FOV: 45 degrees; CFP: 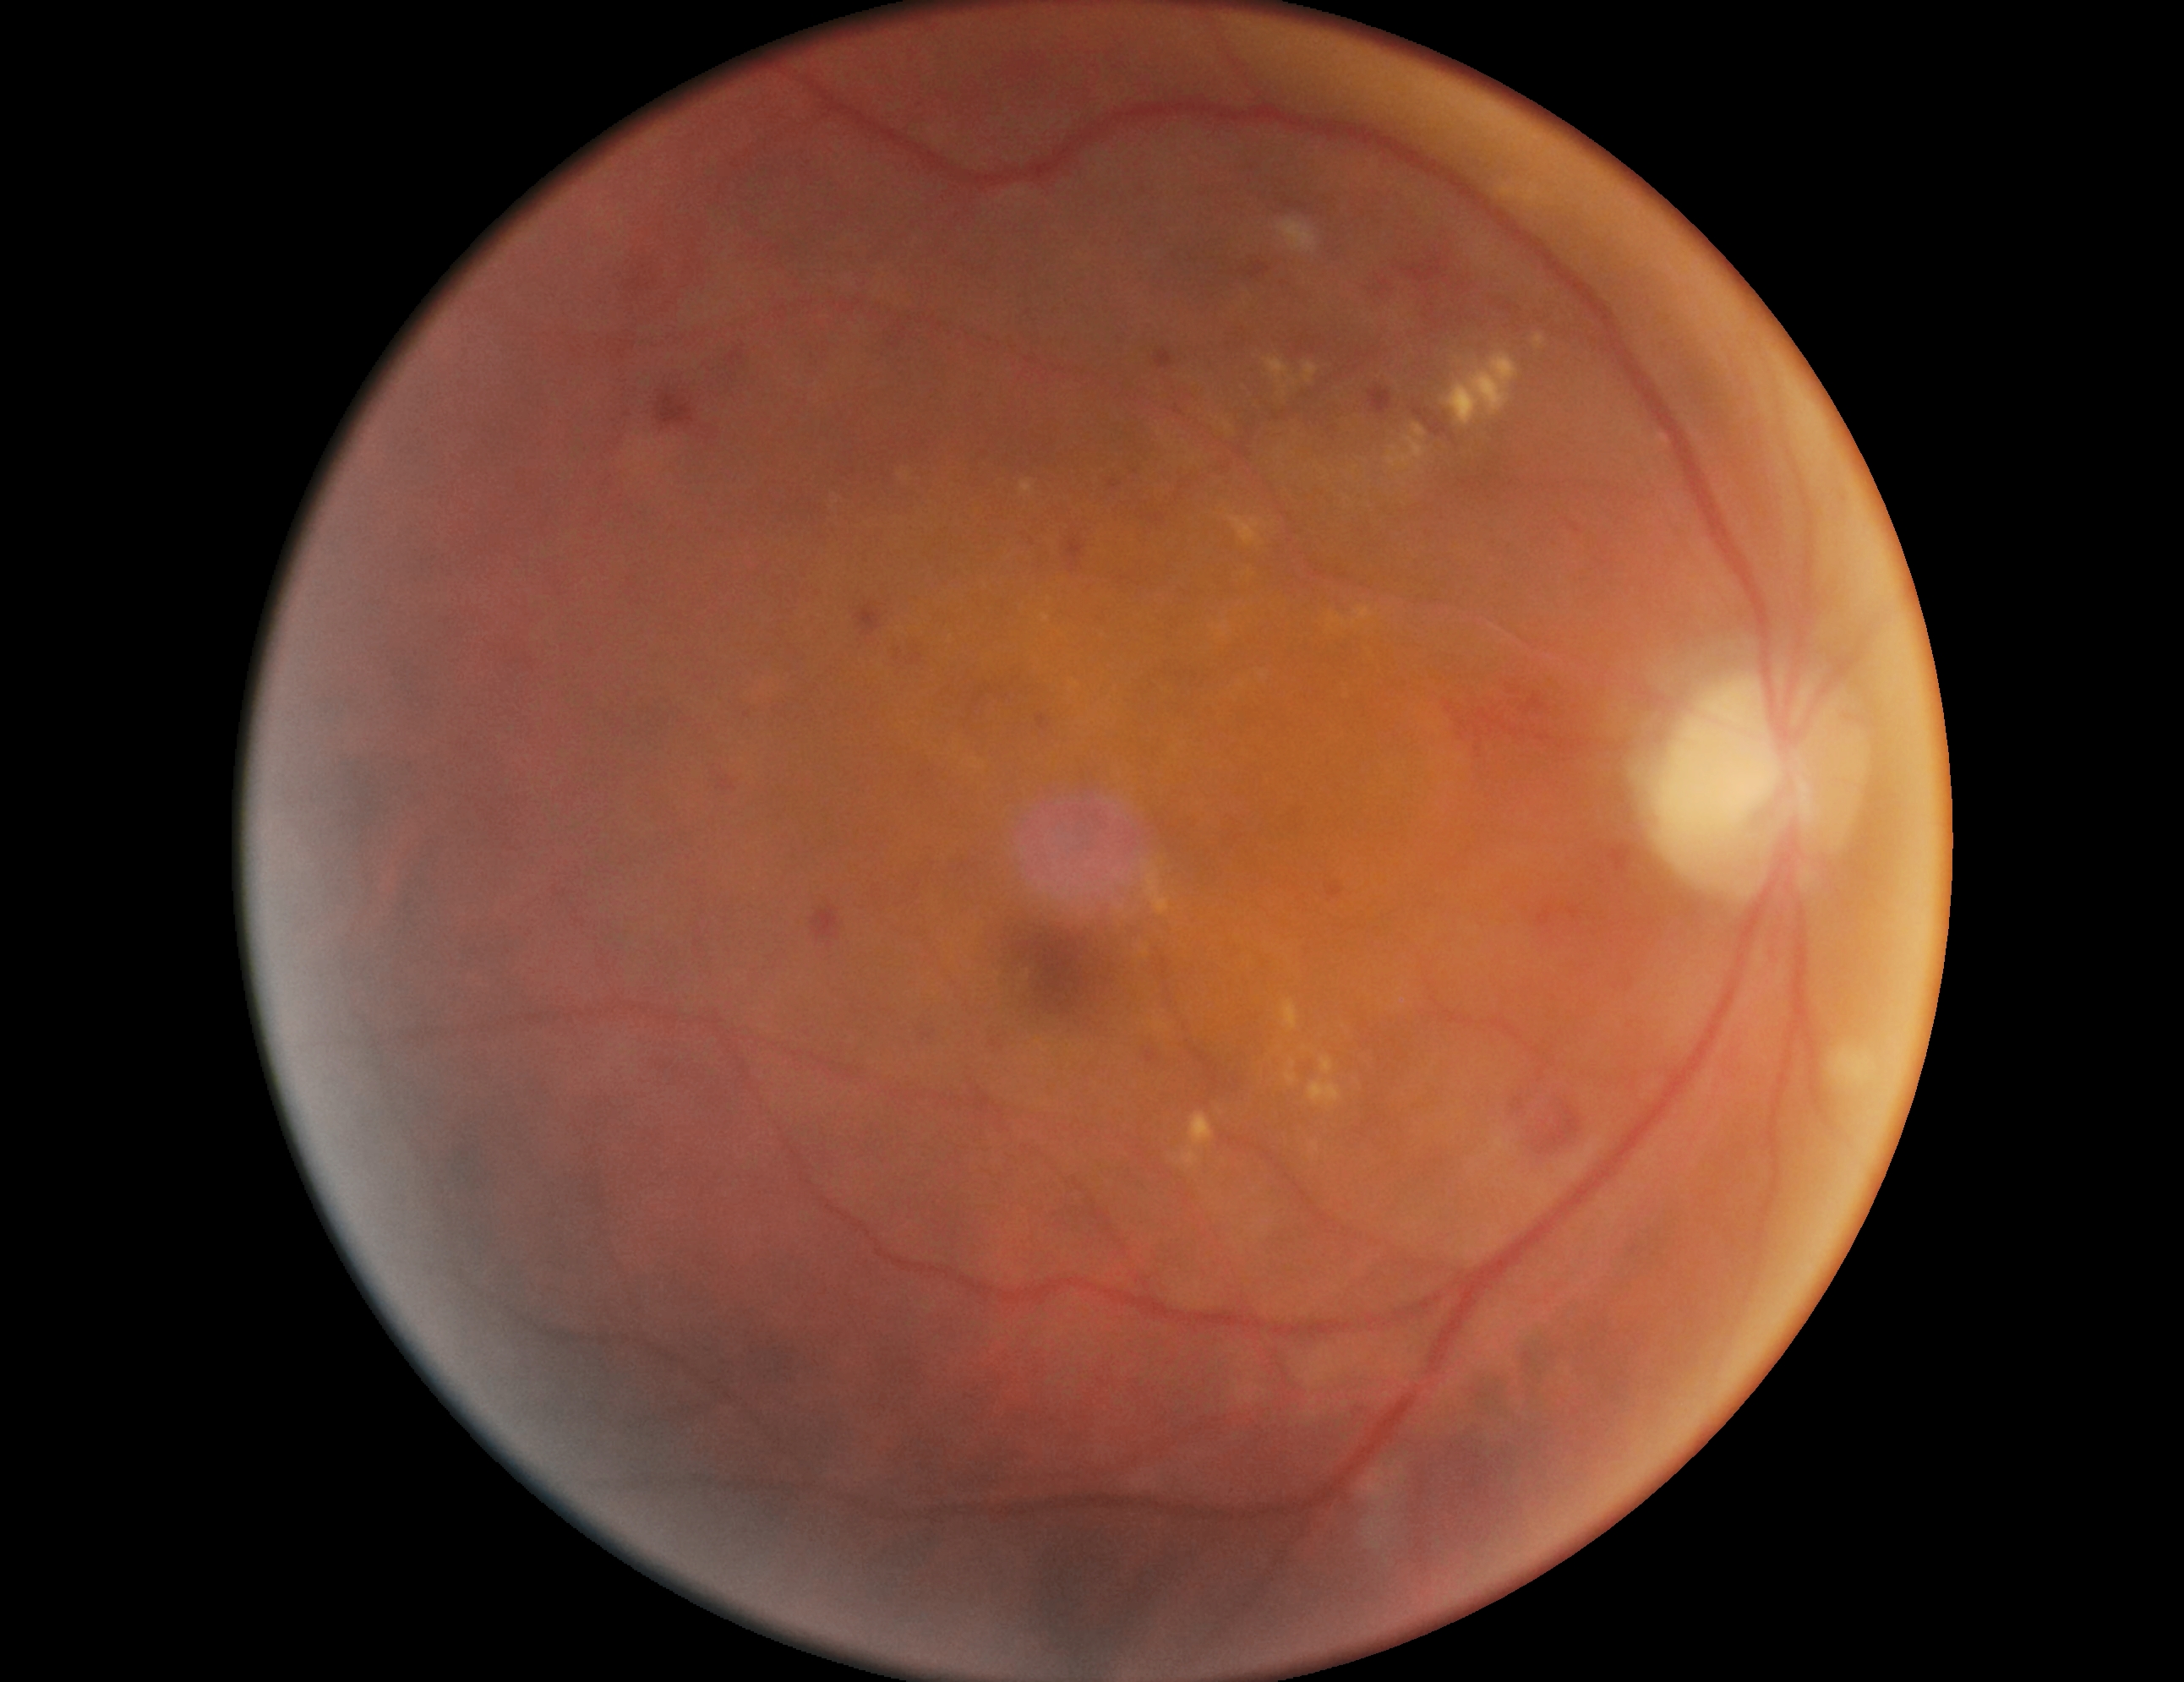
Diabetic retinopathy grade is moderate non-proliferative diabetic retinopathy (2). Disease class: non-proliferative diabetic retinopathy.